Fundus photo; image size 2228x1652.
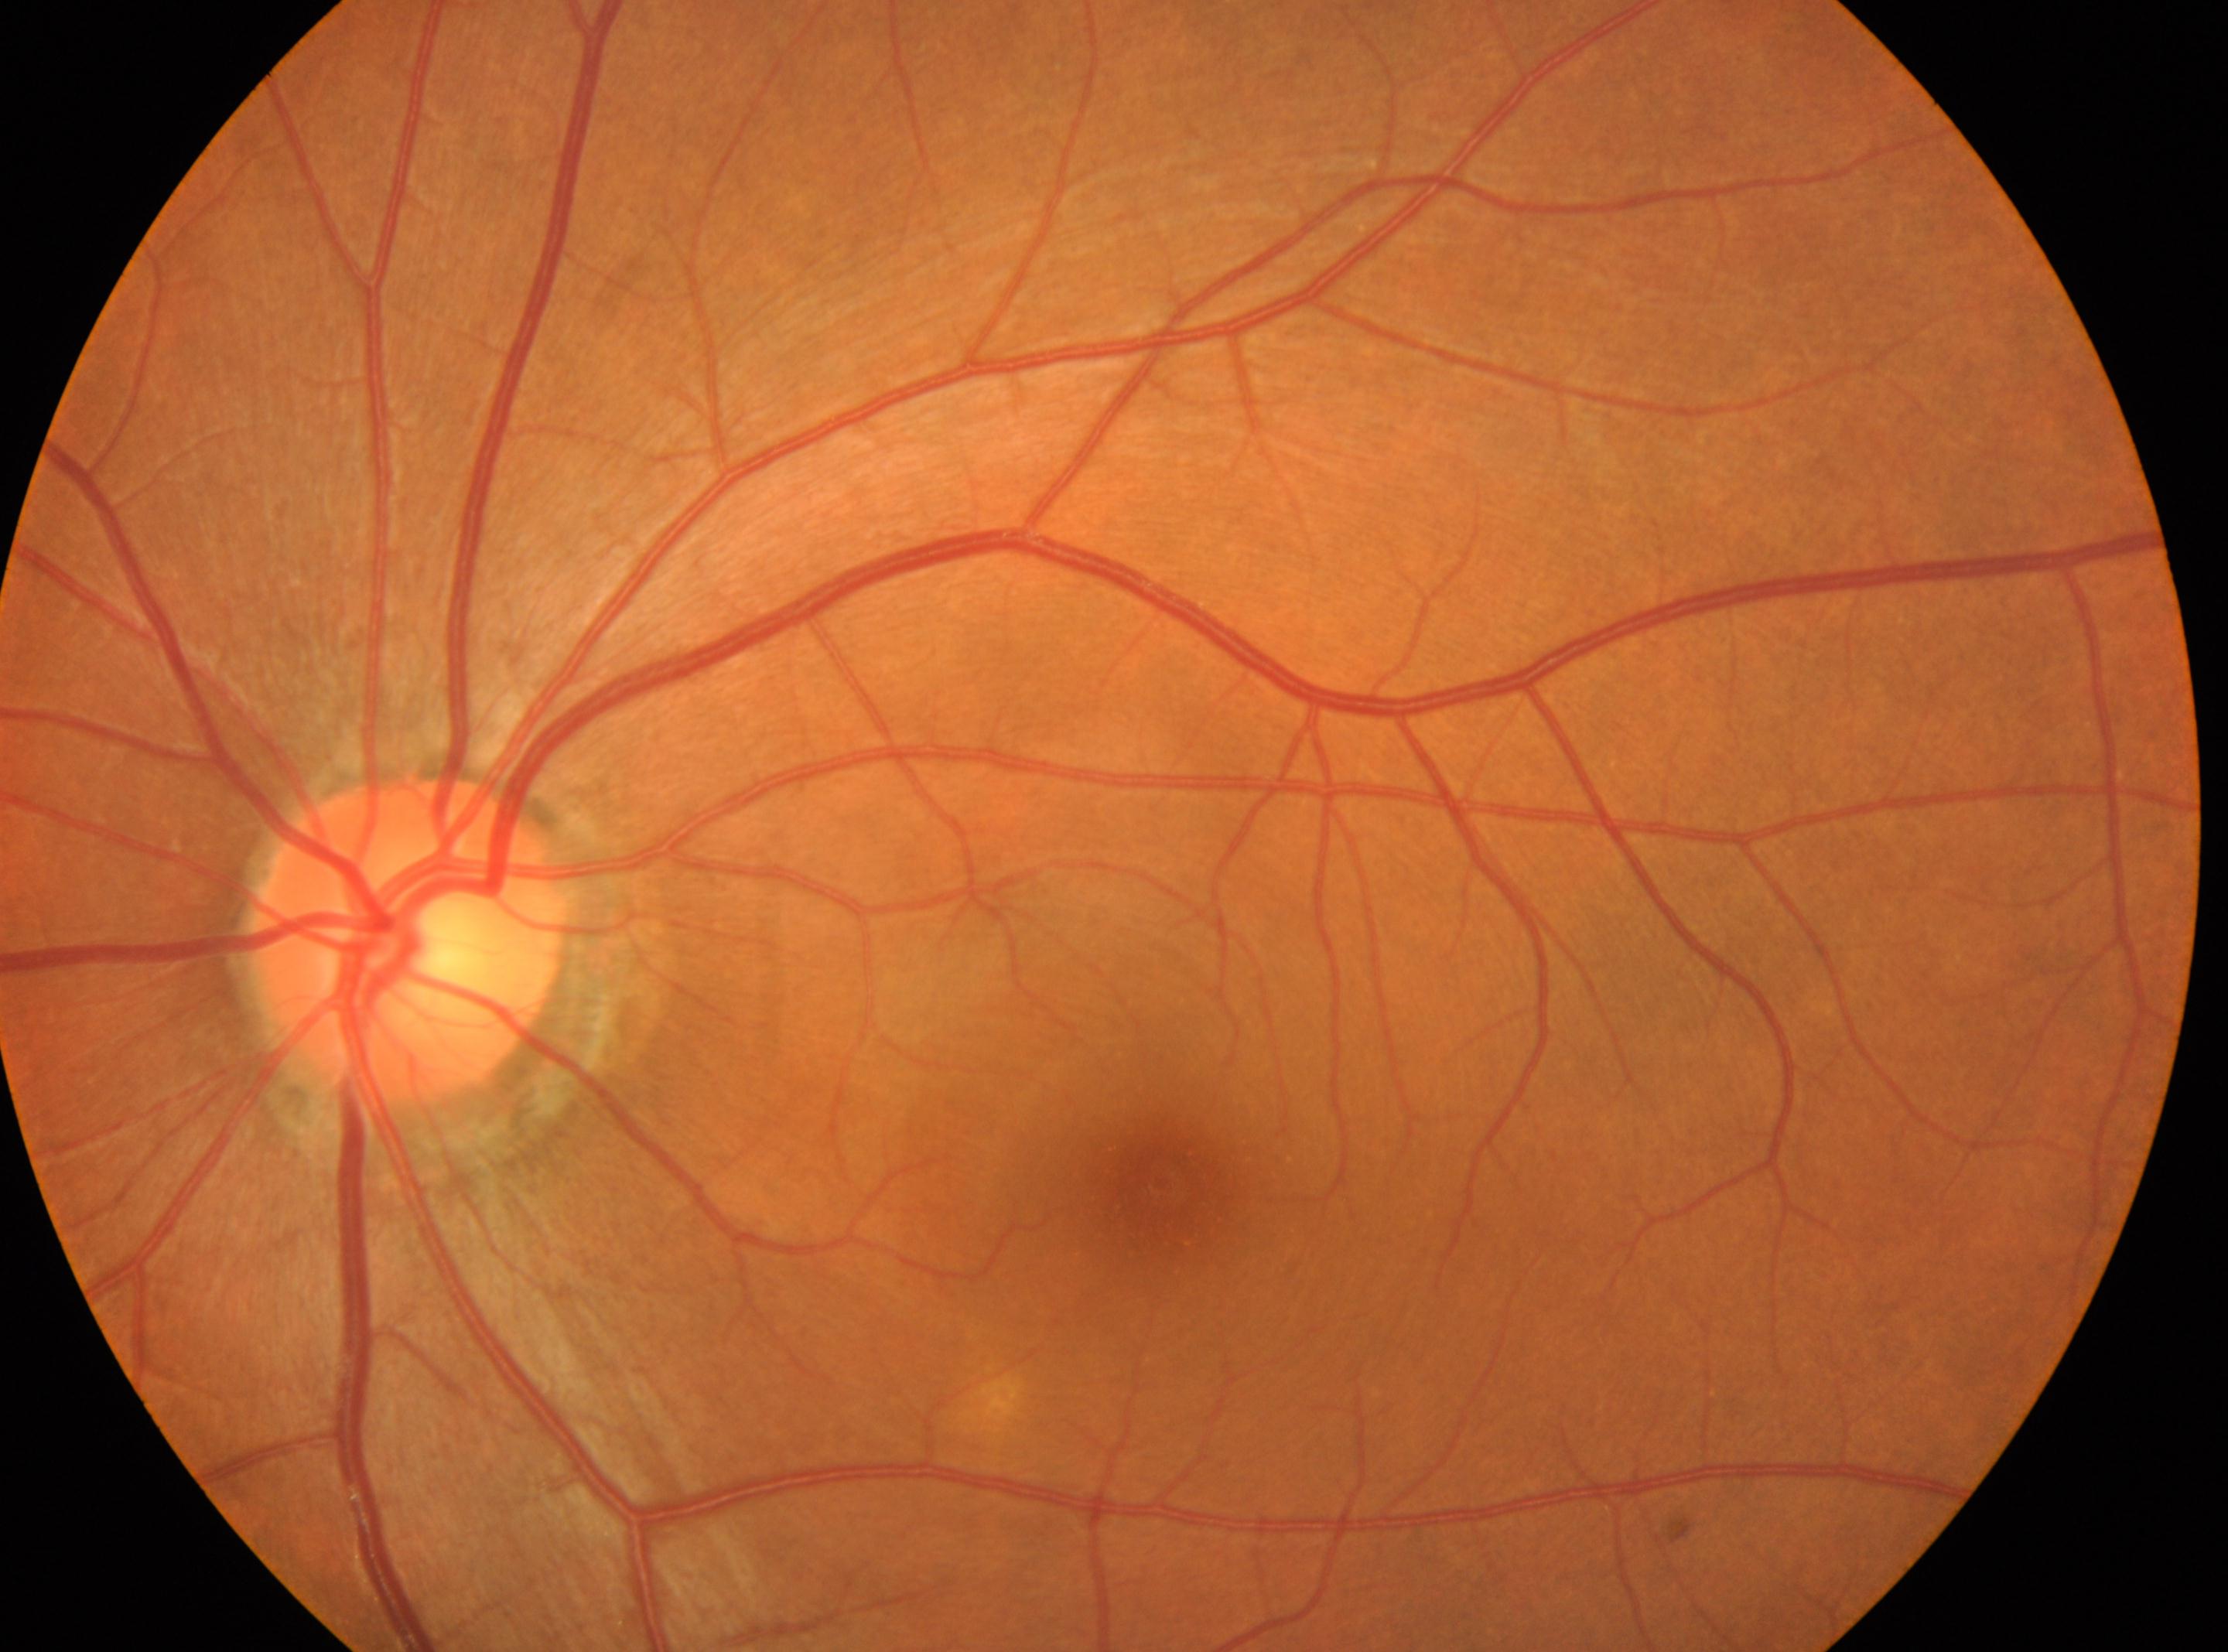 Q: Where is the optic disc?
A: 407px, 939px
Q: Fovea center?
A: 1162px, 1183px
Q: Diabetic retinopathy severity?
A: grade 0
Q: Right or left eye?
A: left